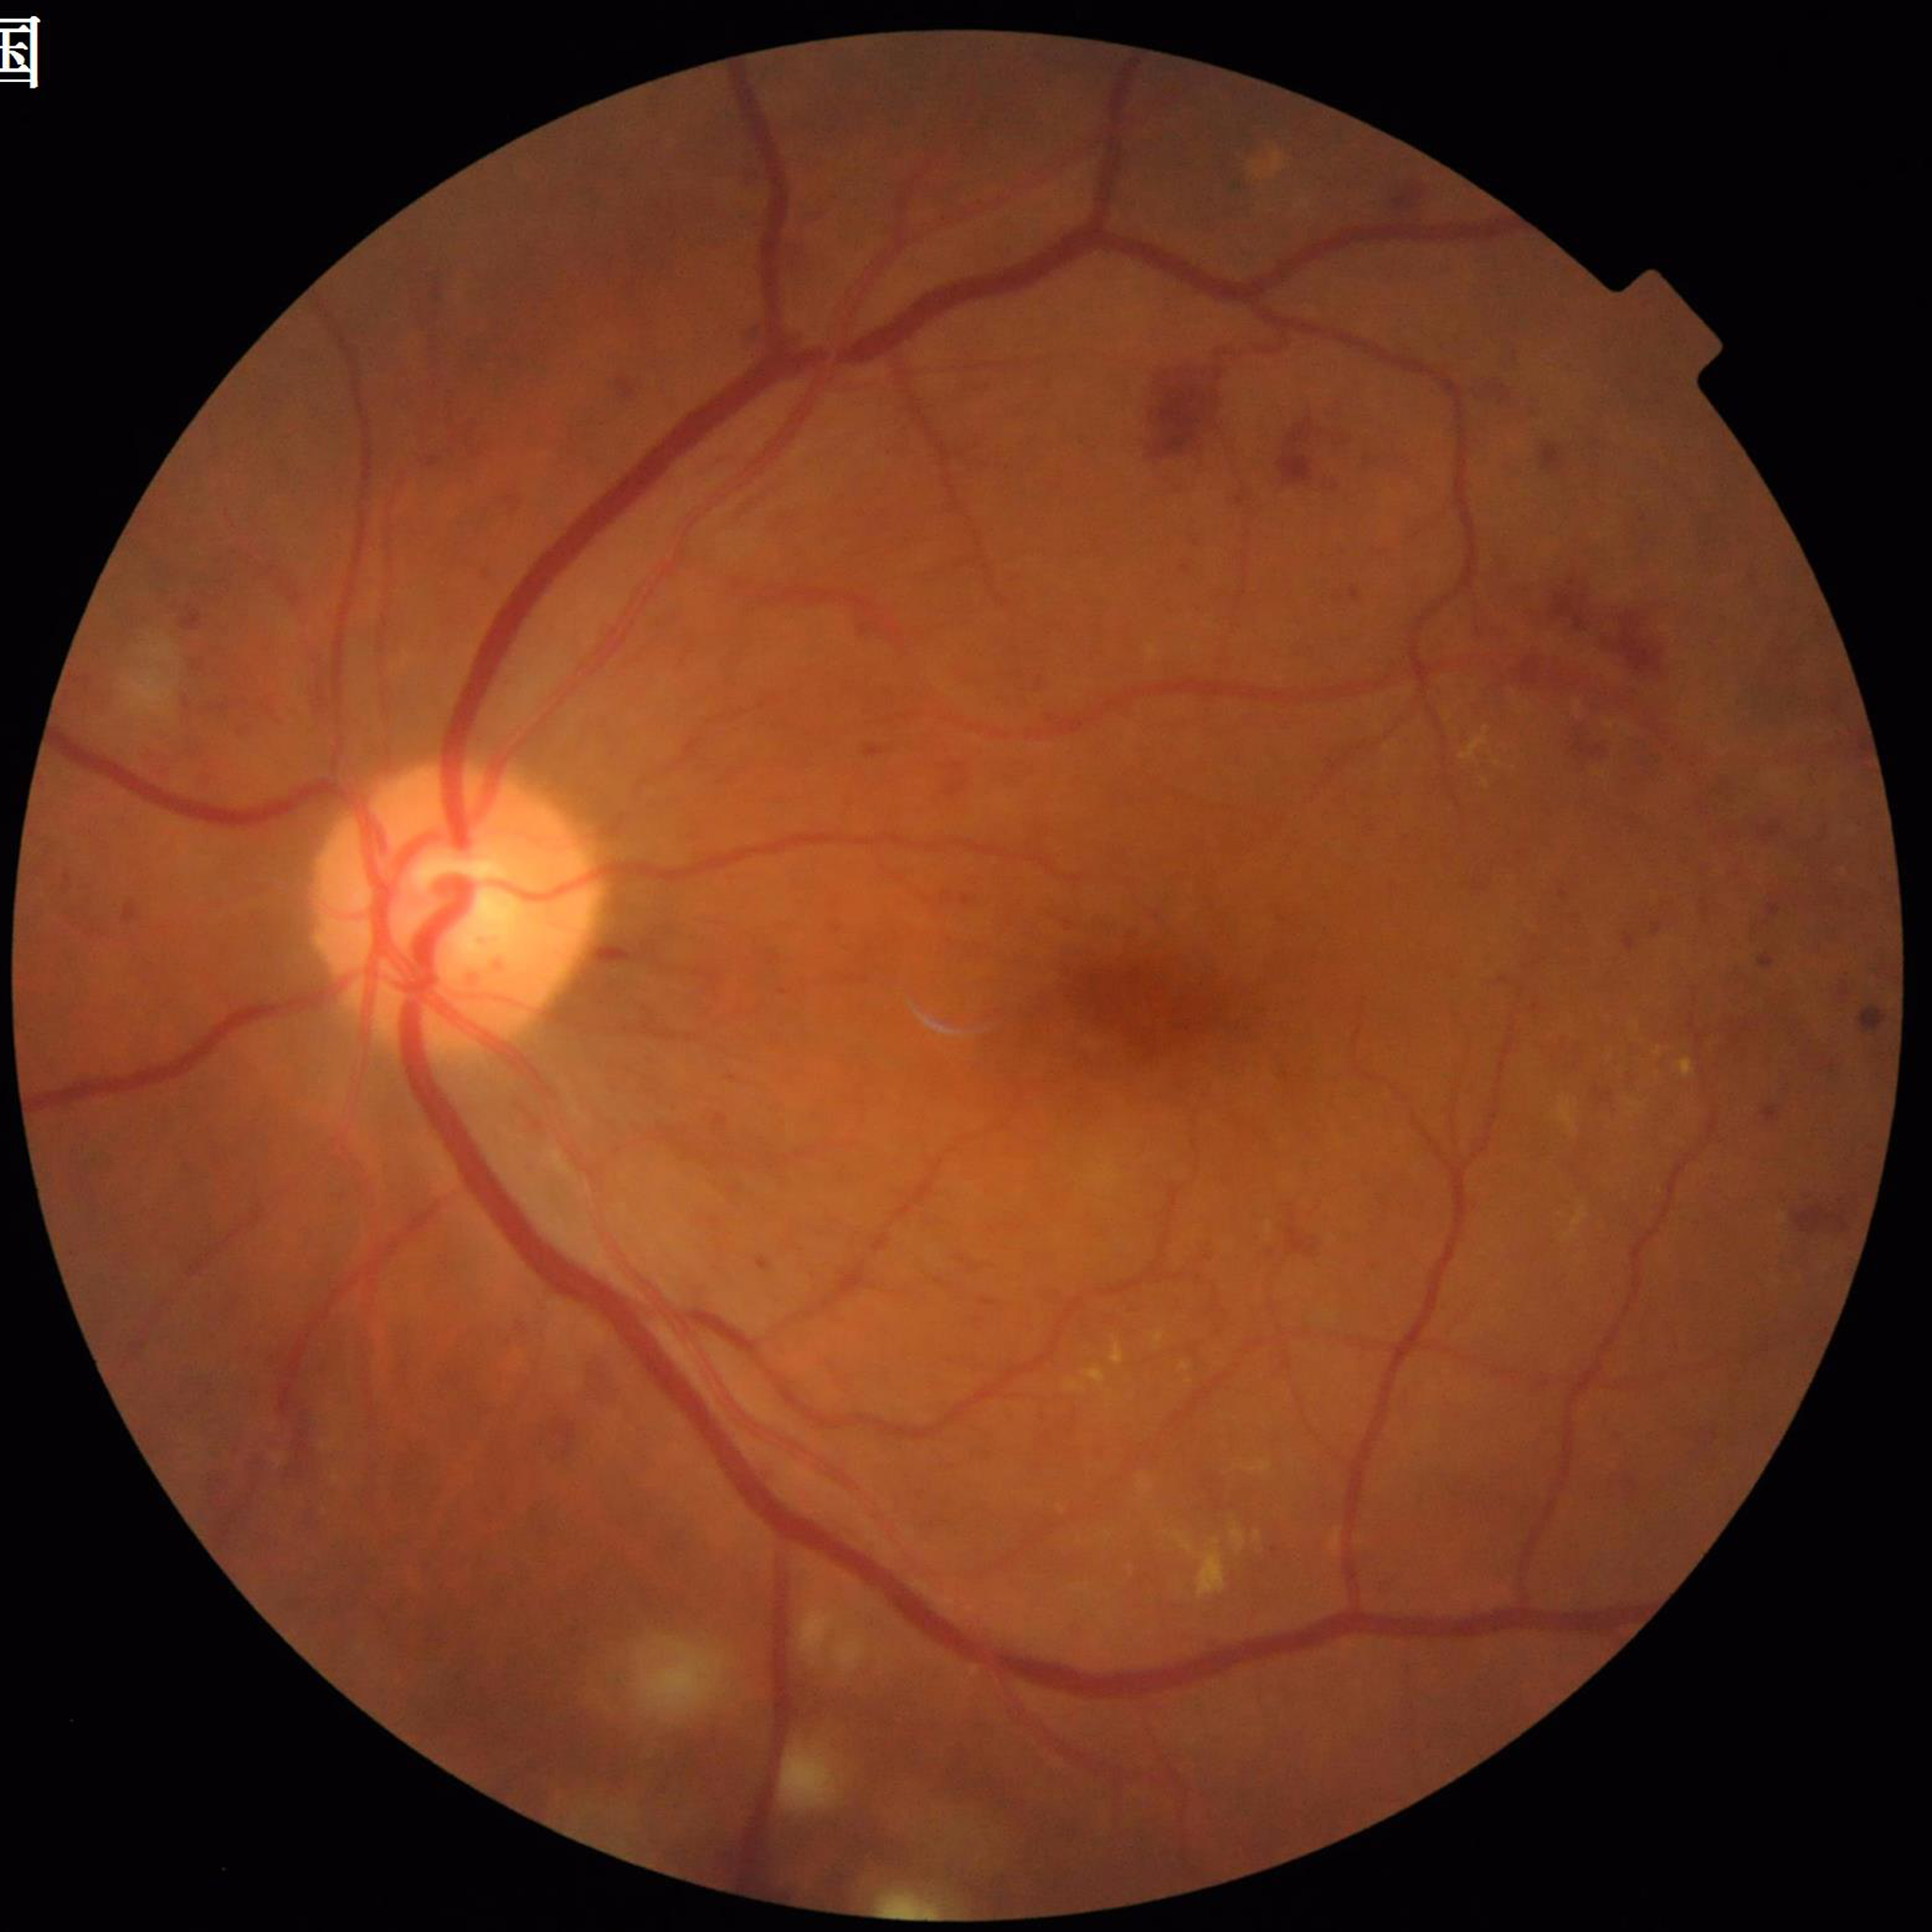
Photo quality: good.
Diagnosed with diabetic retinopathy.